Acquired with a NIDEK AFC-230, modified Davis classification, 848x848px:
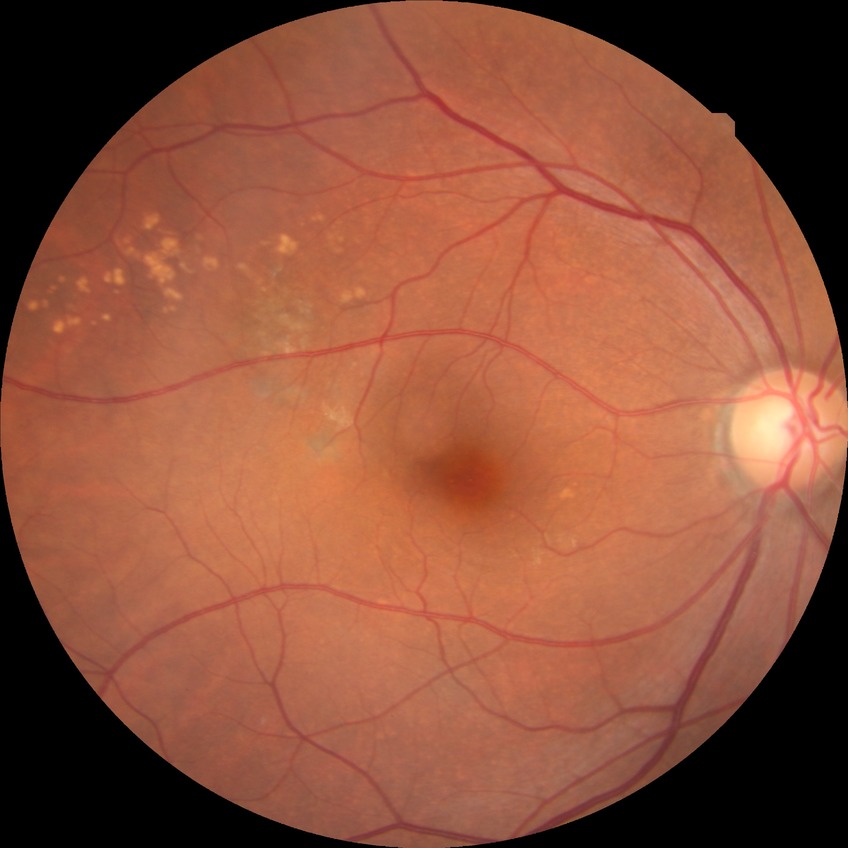
Diabetic retinopathy severity: no diabetic retinopathy.